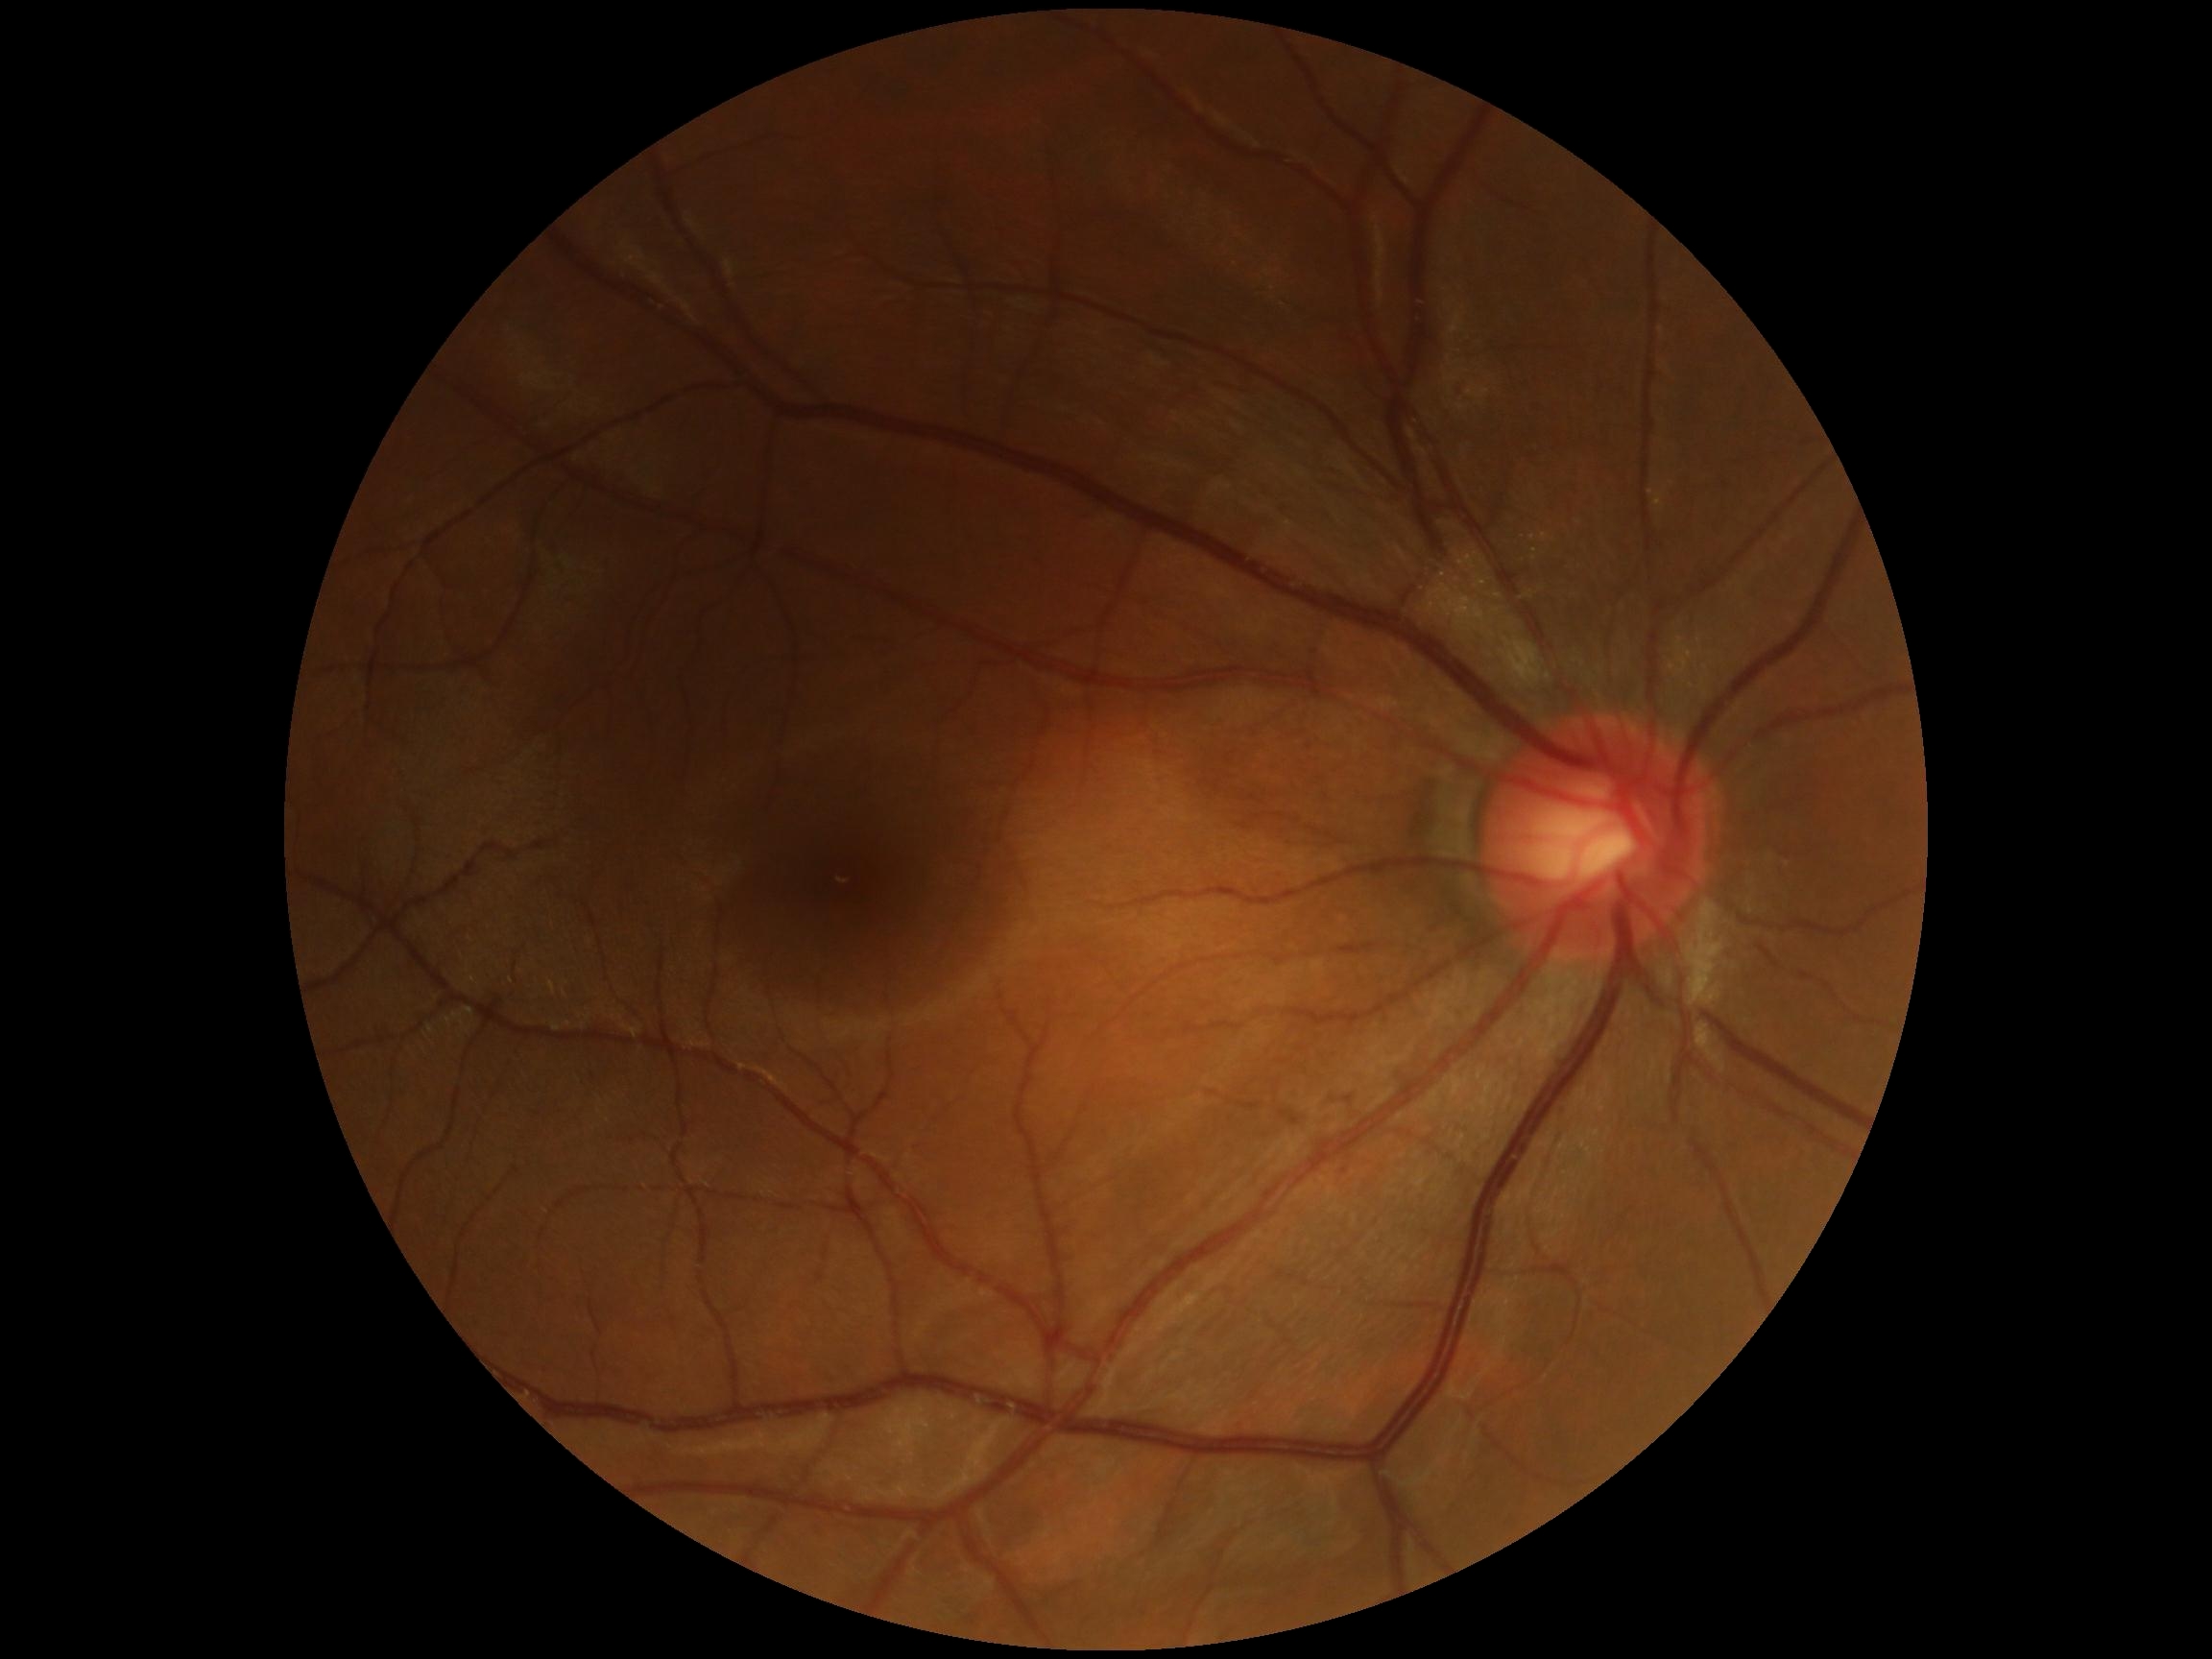

DR severity: 0.